Color fundus image: 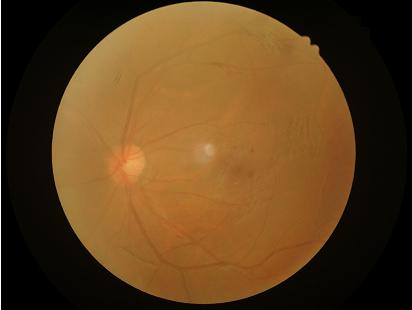
Overall = suboptimal; Contrast = low; Sharpness = poor.